640x480px · wide-field fundus photograph from neonatal ROP screening — 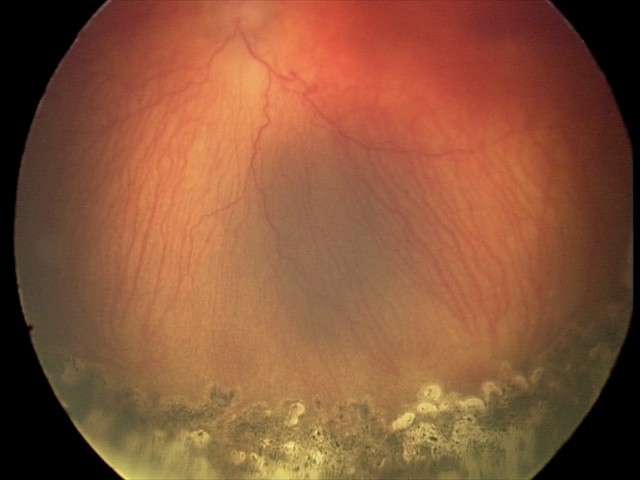
With plus disease. Examination diagnosed as aggressive retinopathy of prematurity (A-ROP) — rapidly progressive severe ROP with prominent plus disease, often without classic stage progression.